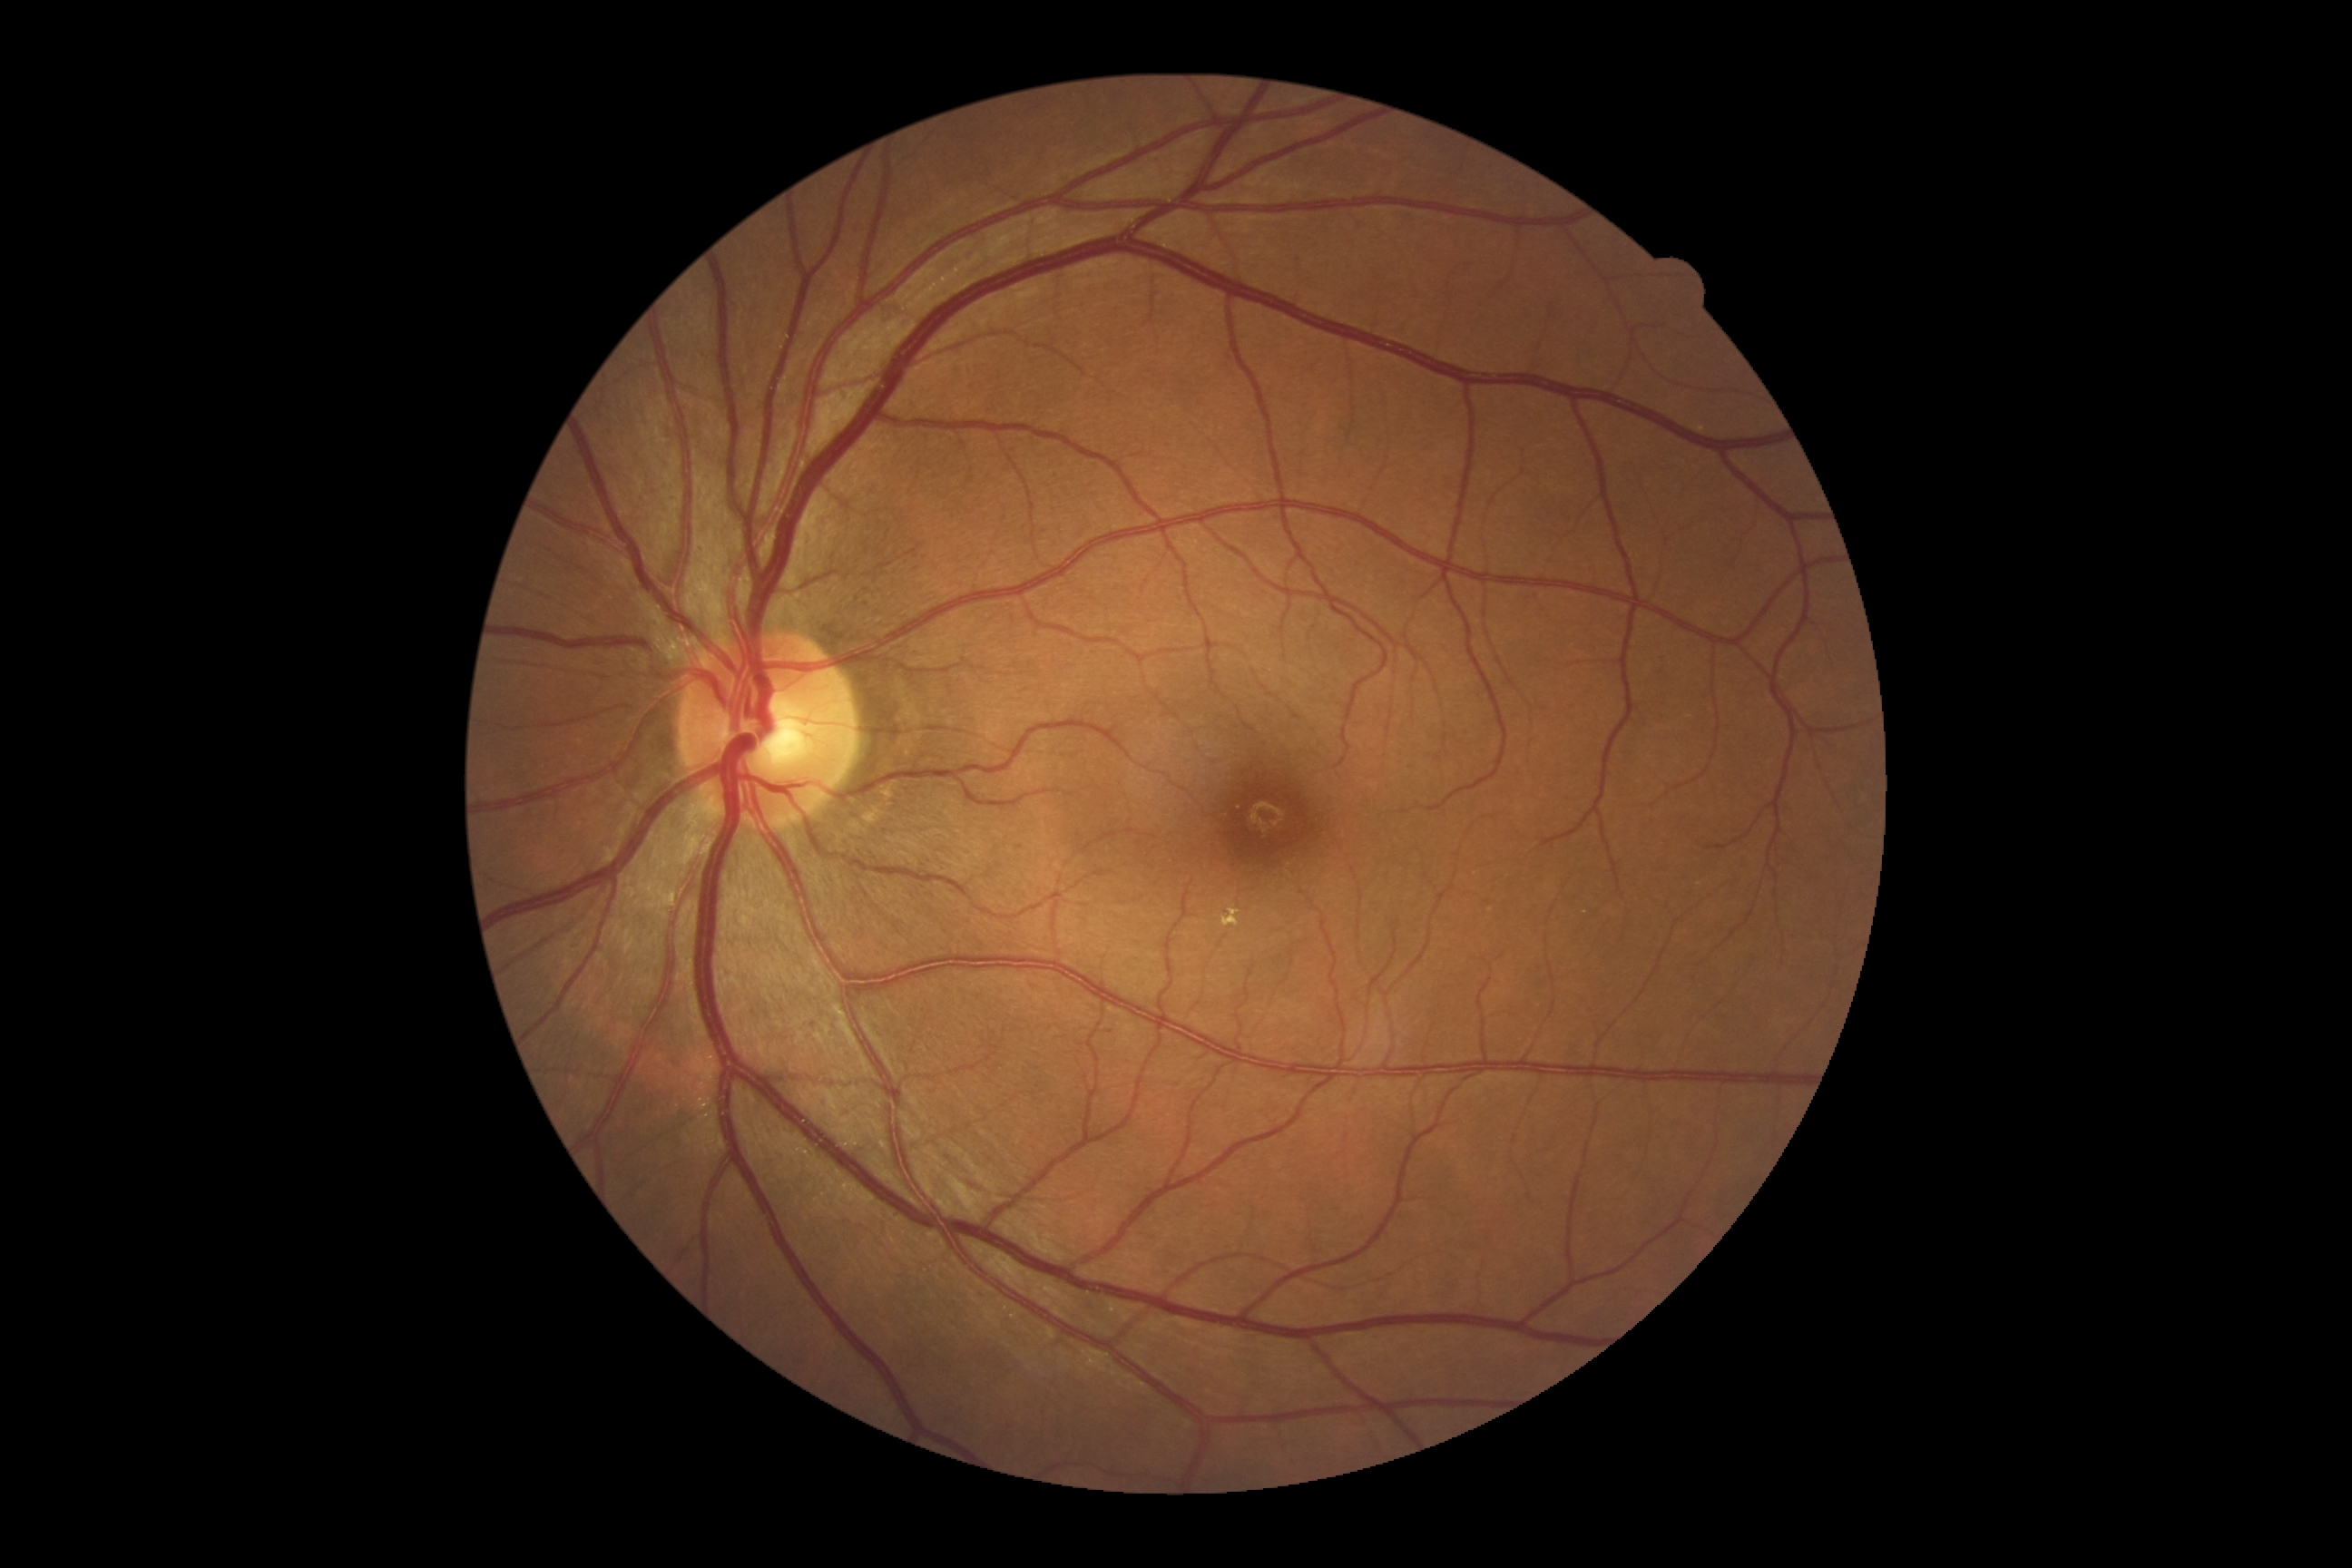

DR severity = 2 | DR class = non-proliferative diabetic retinopathy.